45° field of view · 2352x1568px · color fundus image.
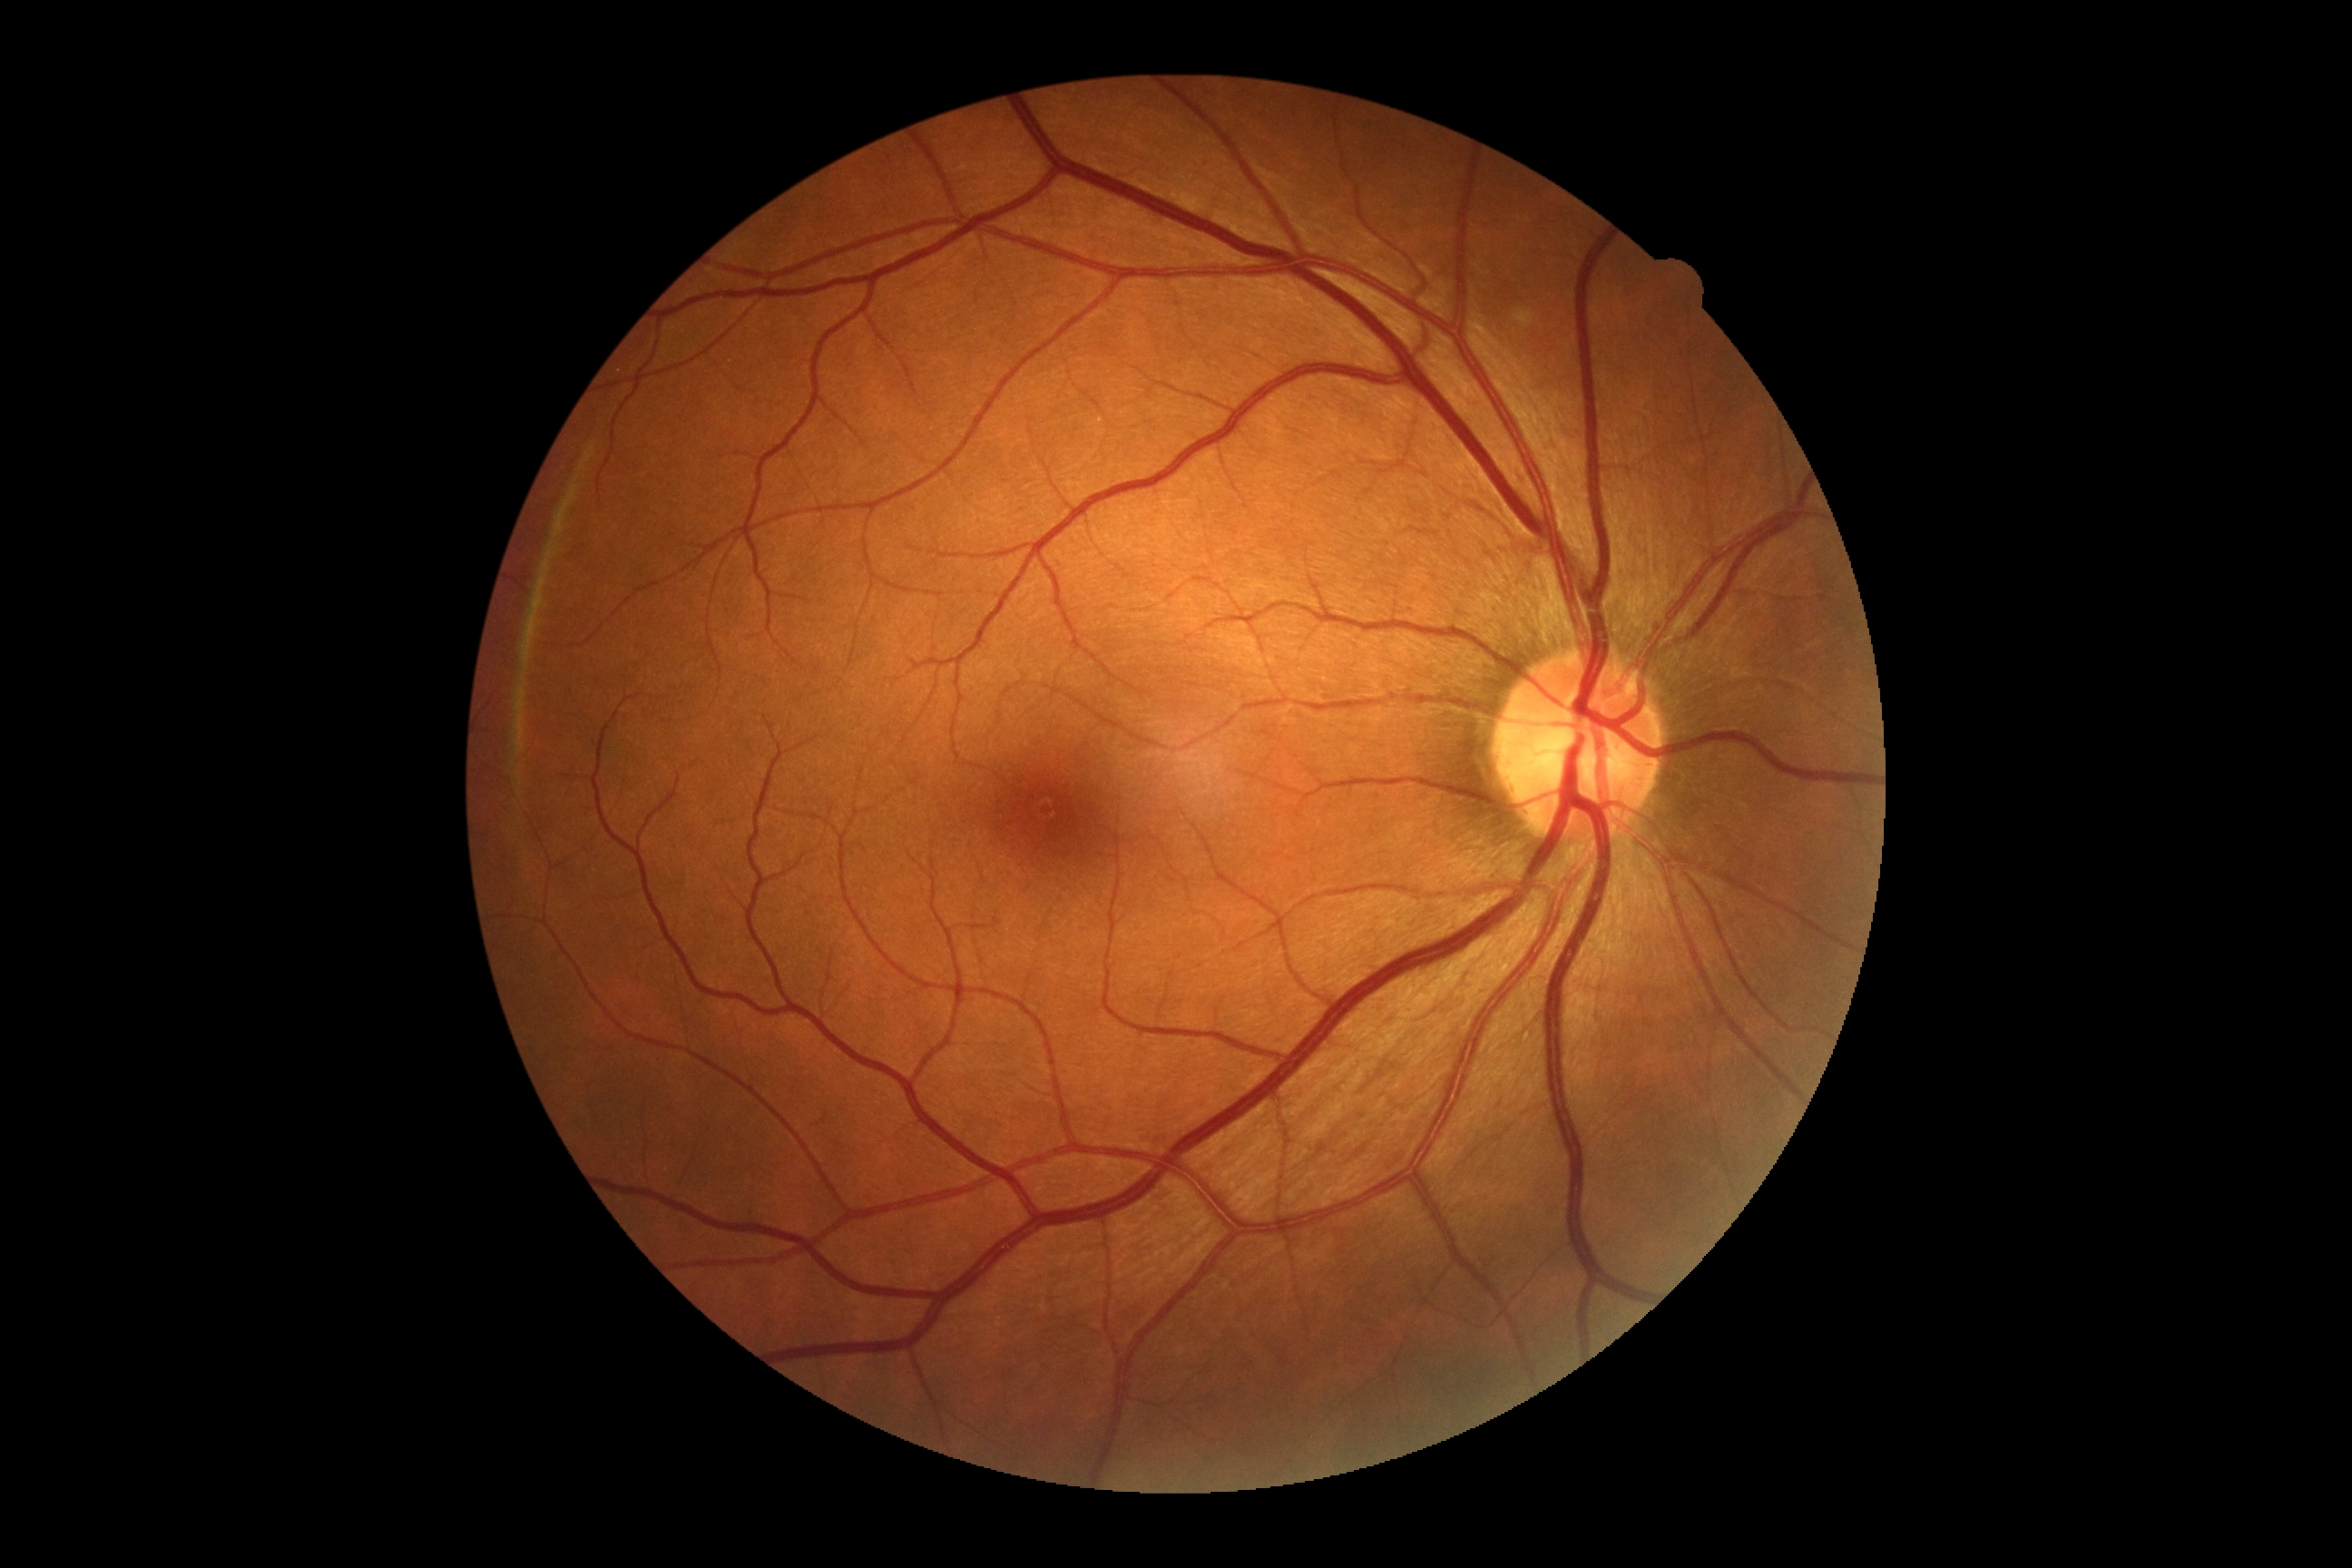
{"dr_grade": "no apparent diabetic retinopathy (0)"}